1240x1240px; wide-field fundus image from infant ROP screening — 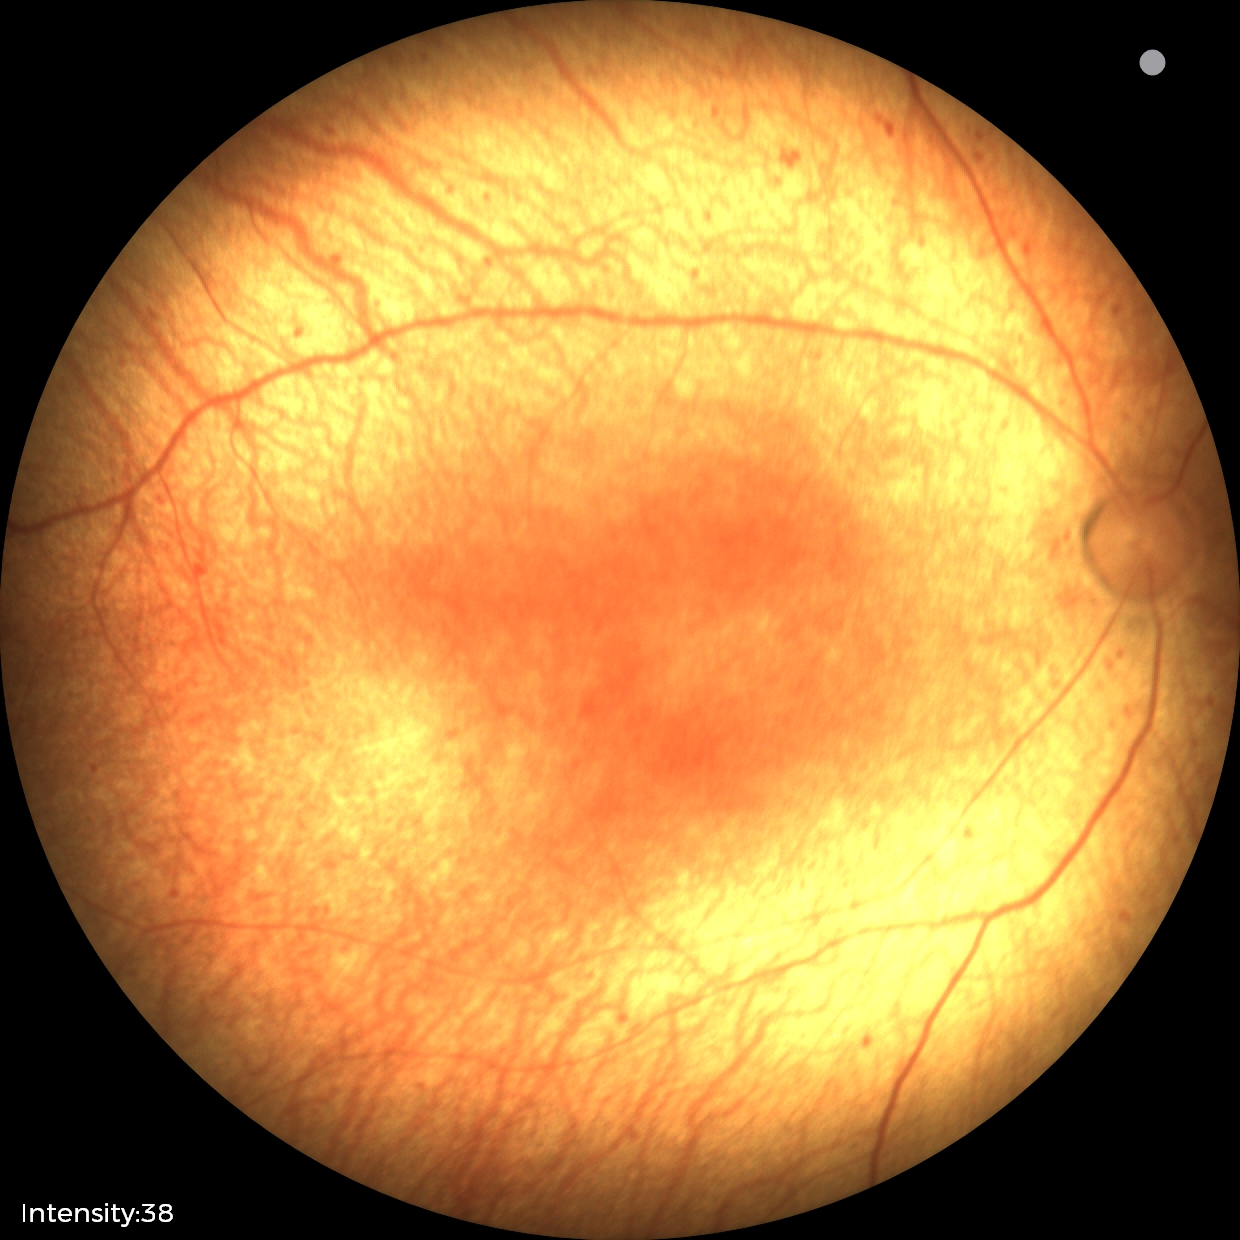

Assessment: status post retinopathy of prematurity (ROP); no plus disease.